2352 x 1568 pixels:
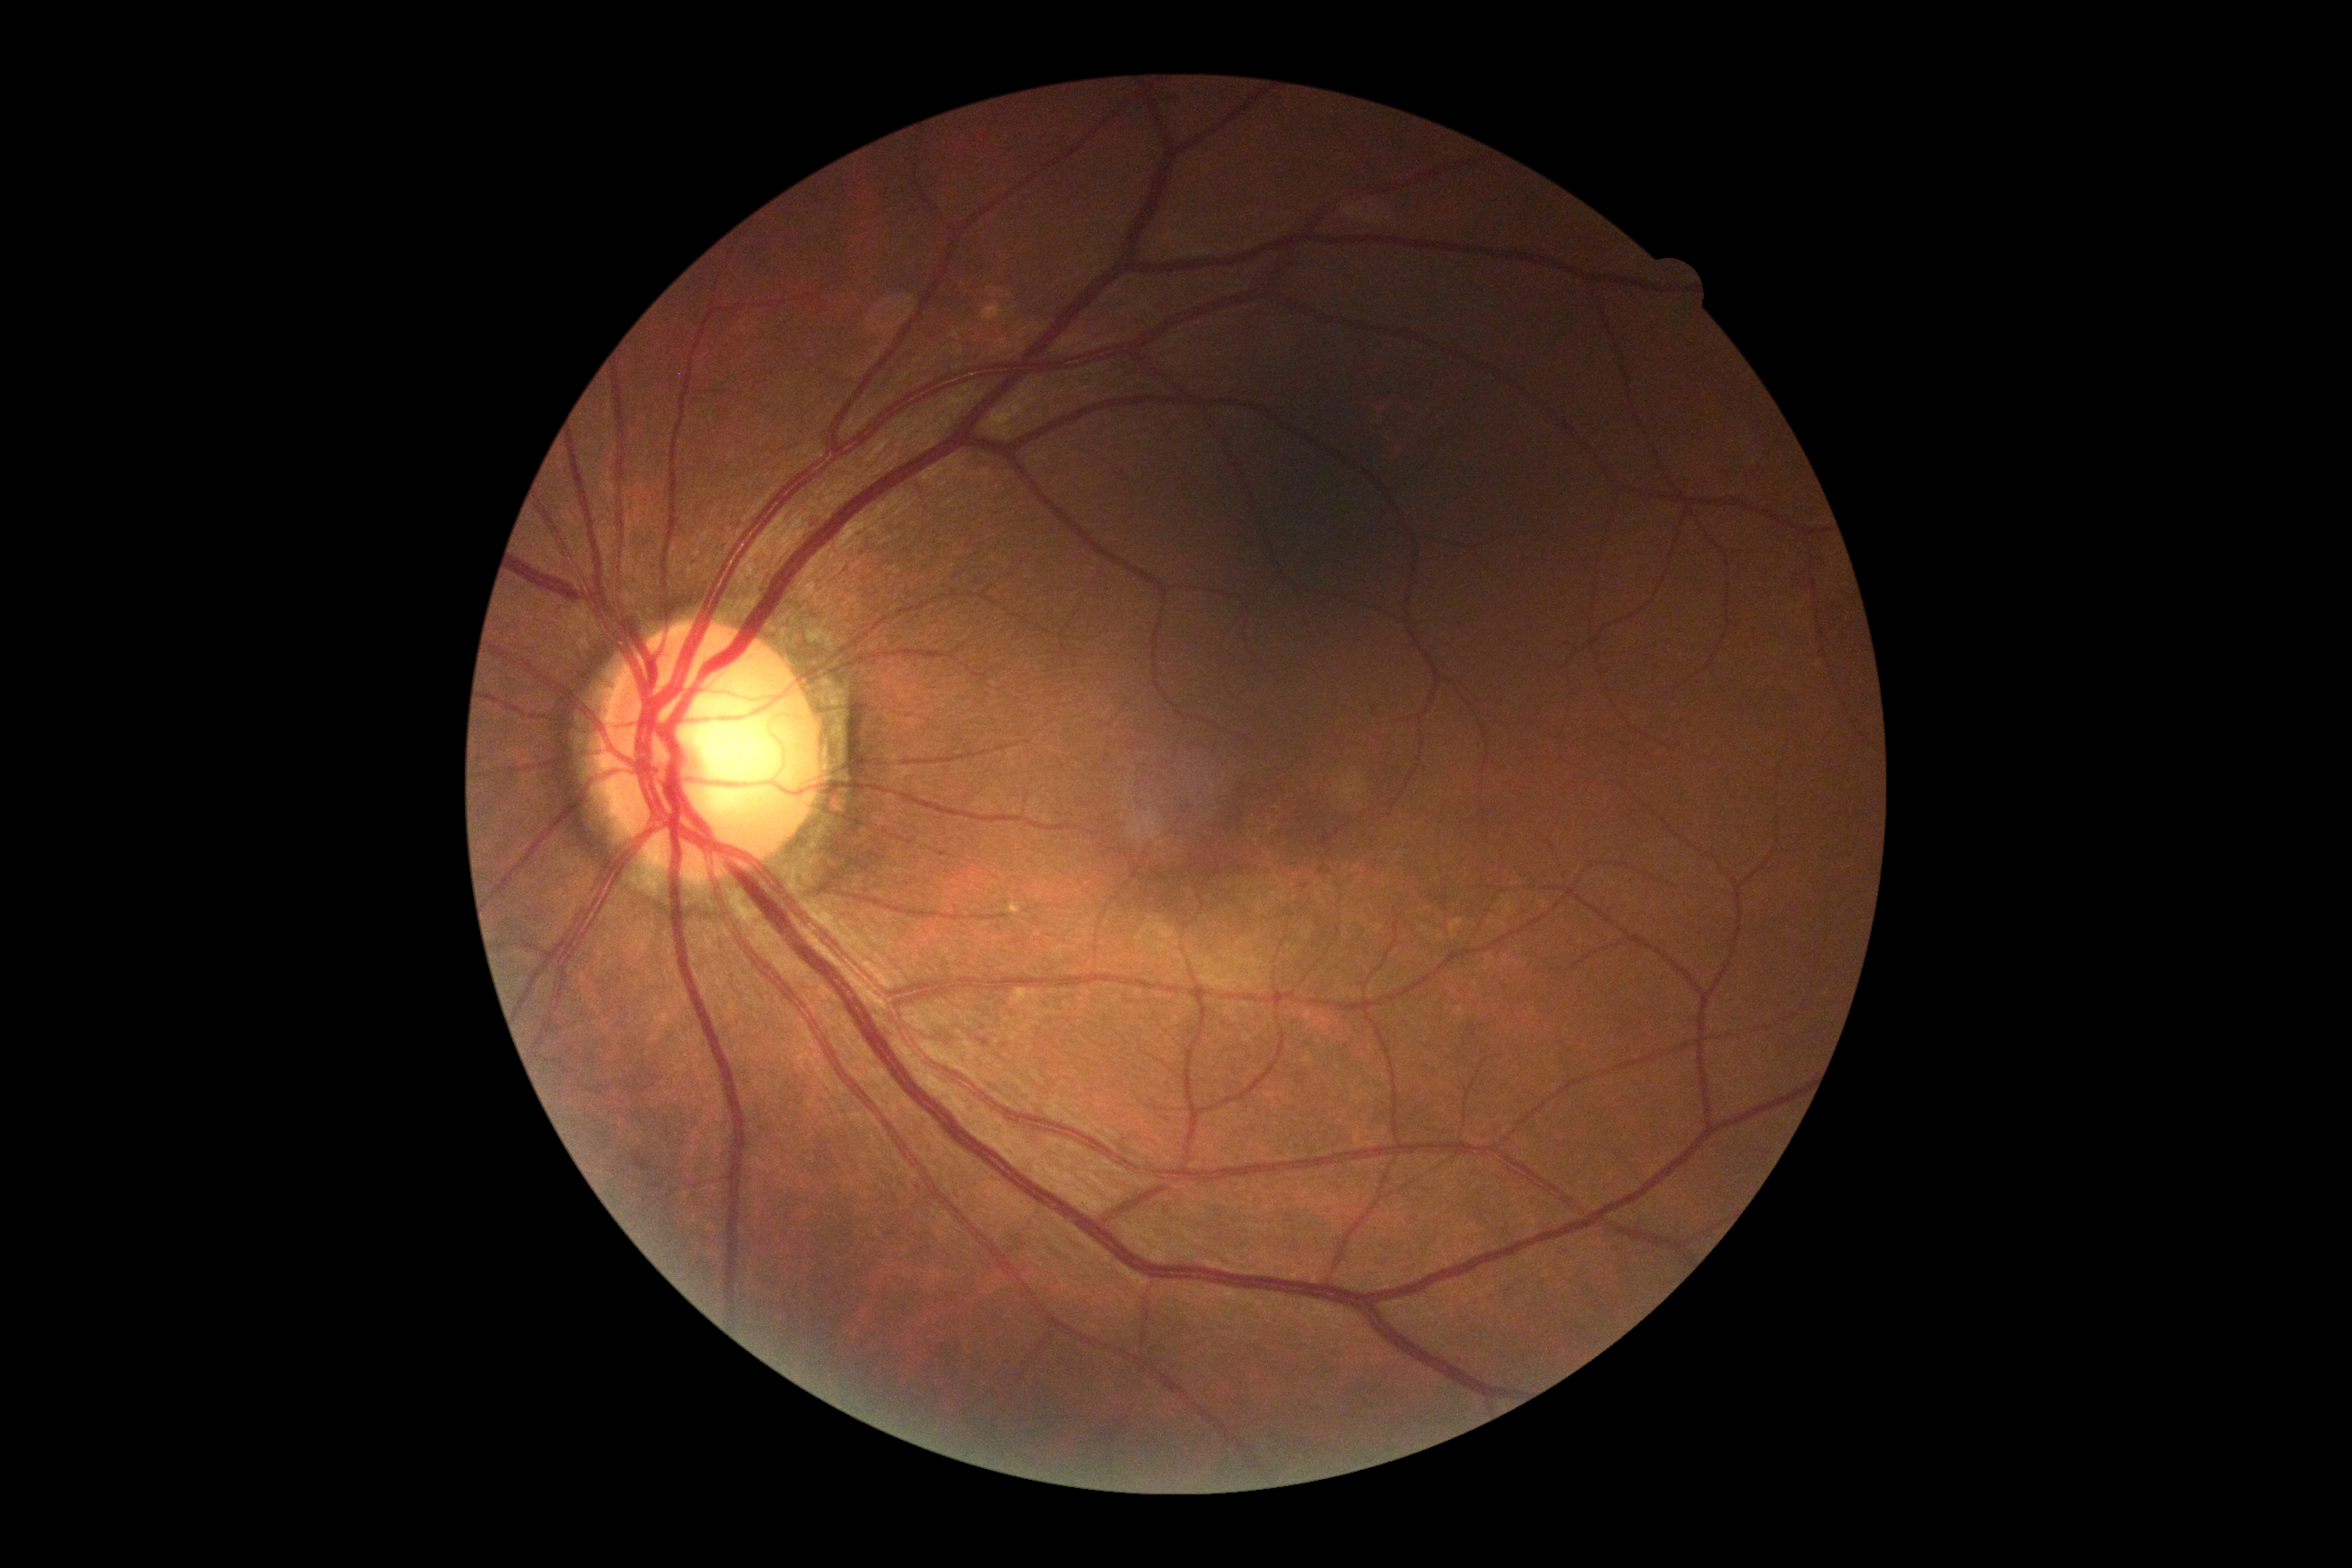 No diabetic retinal disease findings. DR severity is 0 — no visible signs of diabetic retinopathy.